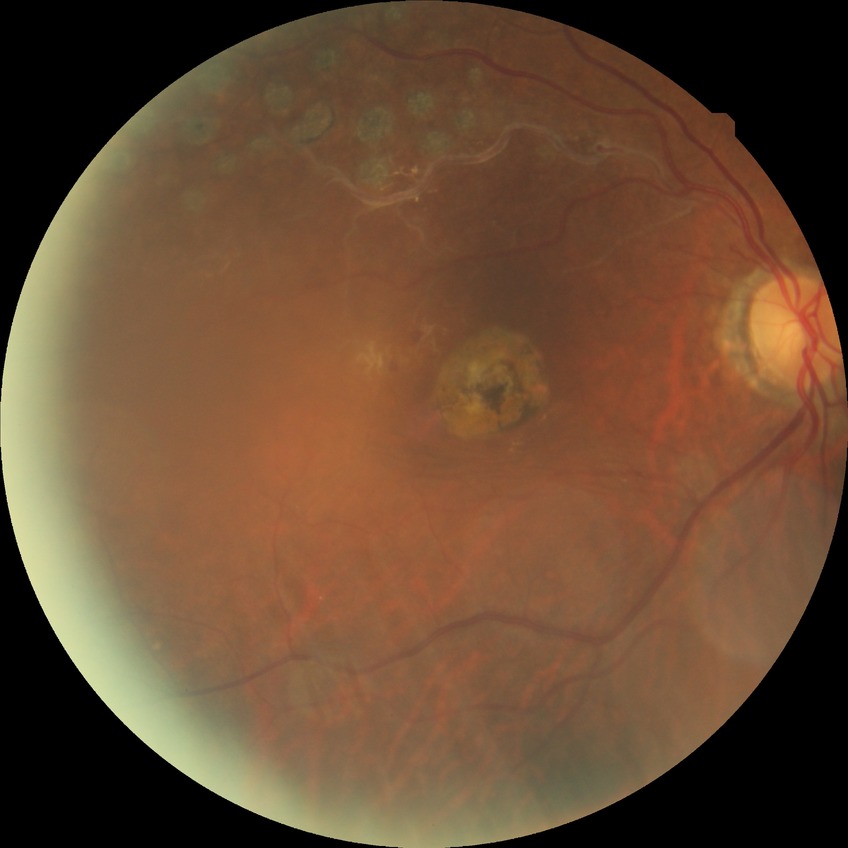 Diabetic retinopathy (DR) is NDR (no diabetic retinopathy).